Acquired with a NIDEK AFC-230, nonmydriatic
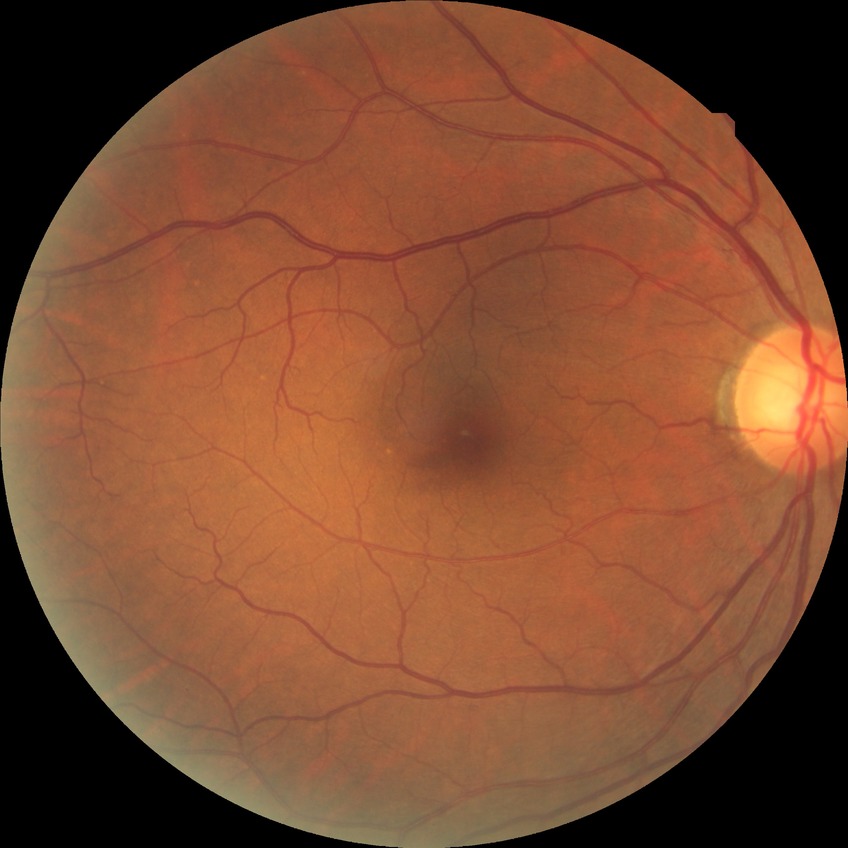
davis_grade: NDR
dr_impression: no DR findings